Color fundus photograph; NIDEK AFC-230 fundus camera:
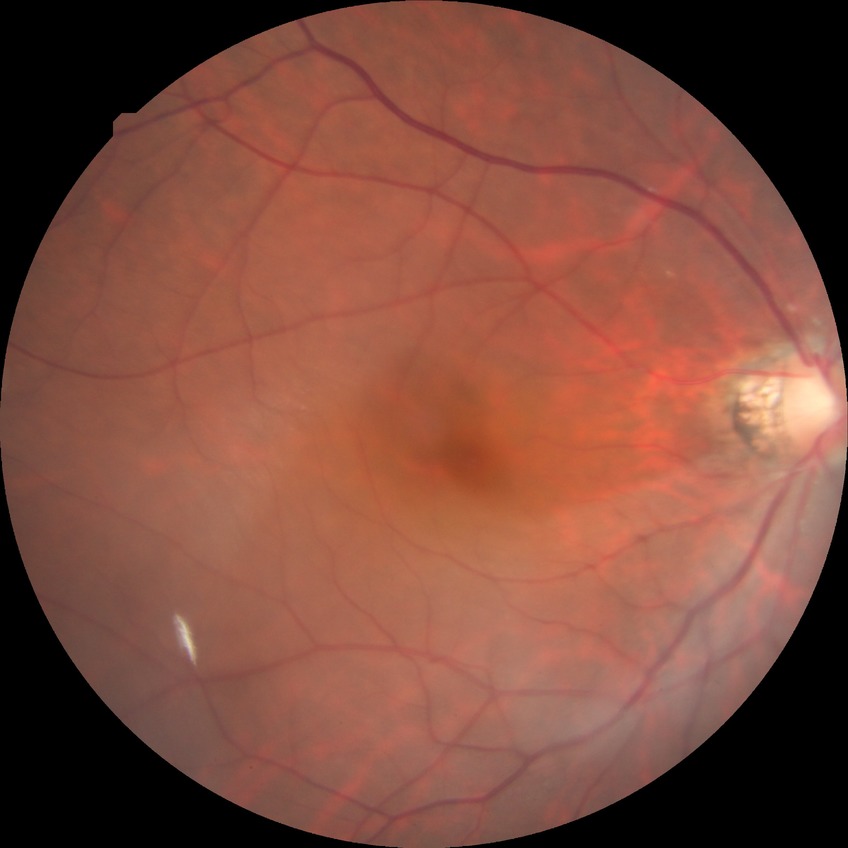

diabetic retinopathy (DR): no diabetic retinopathy (NDR).